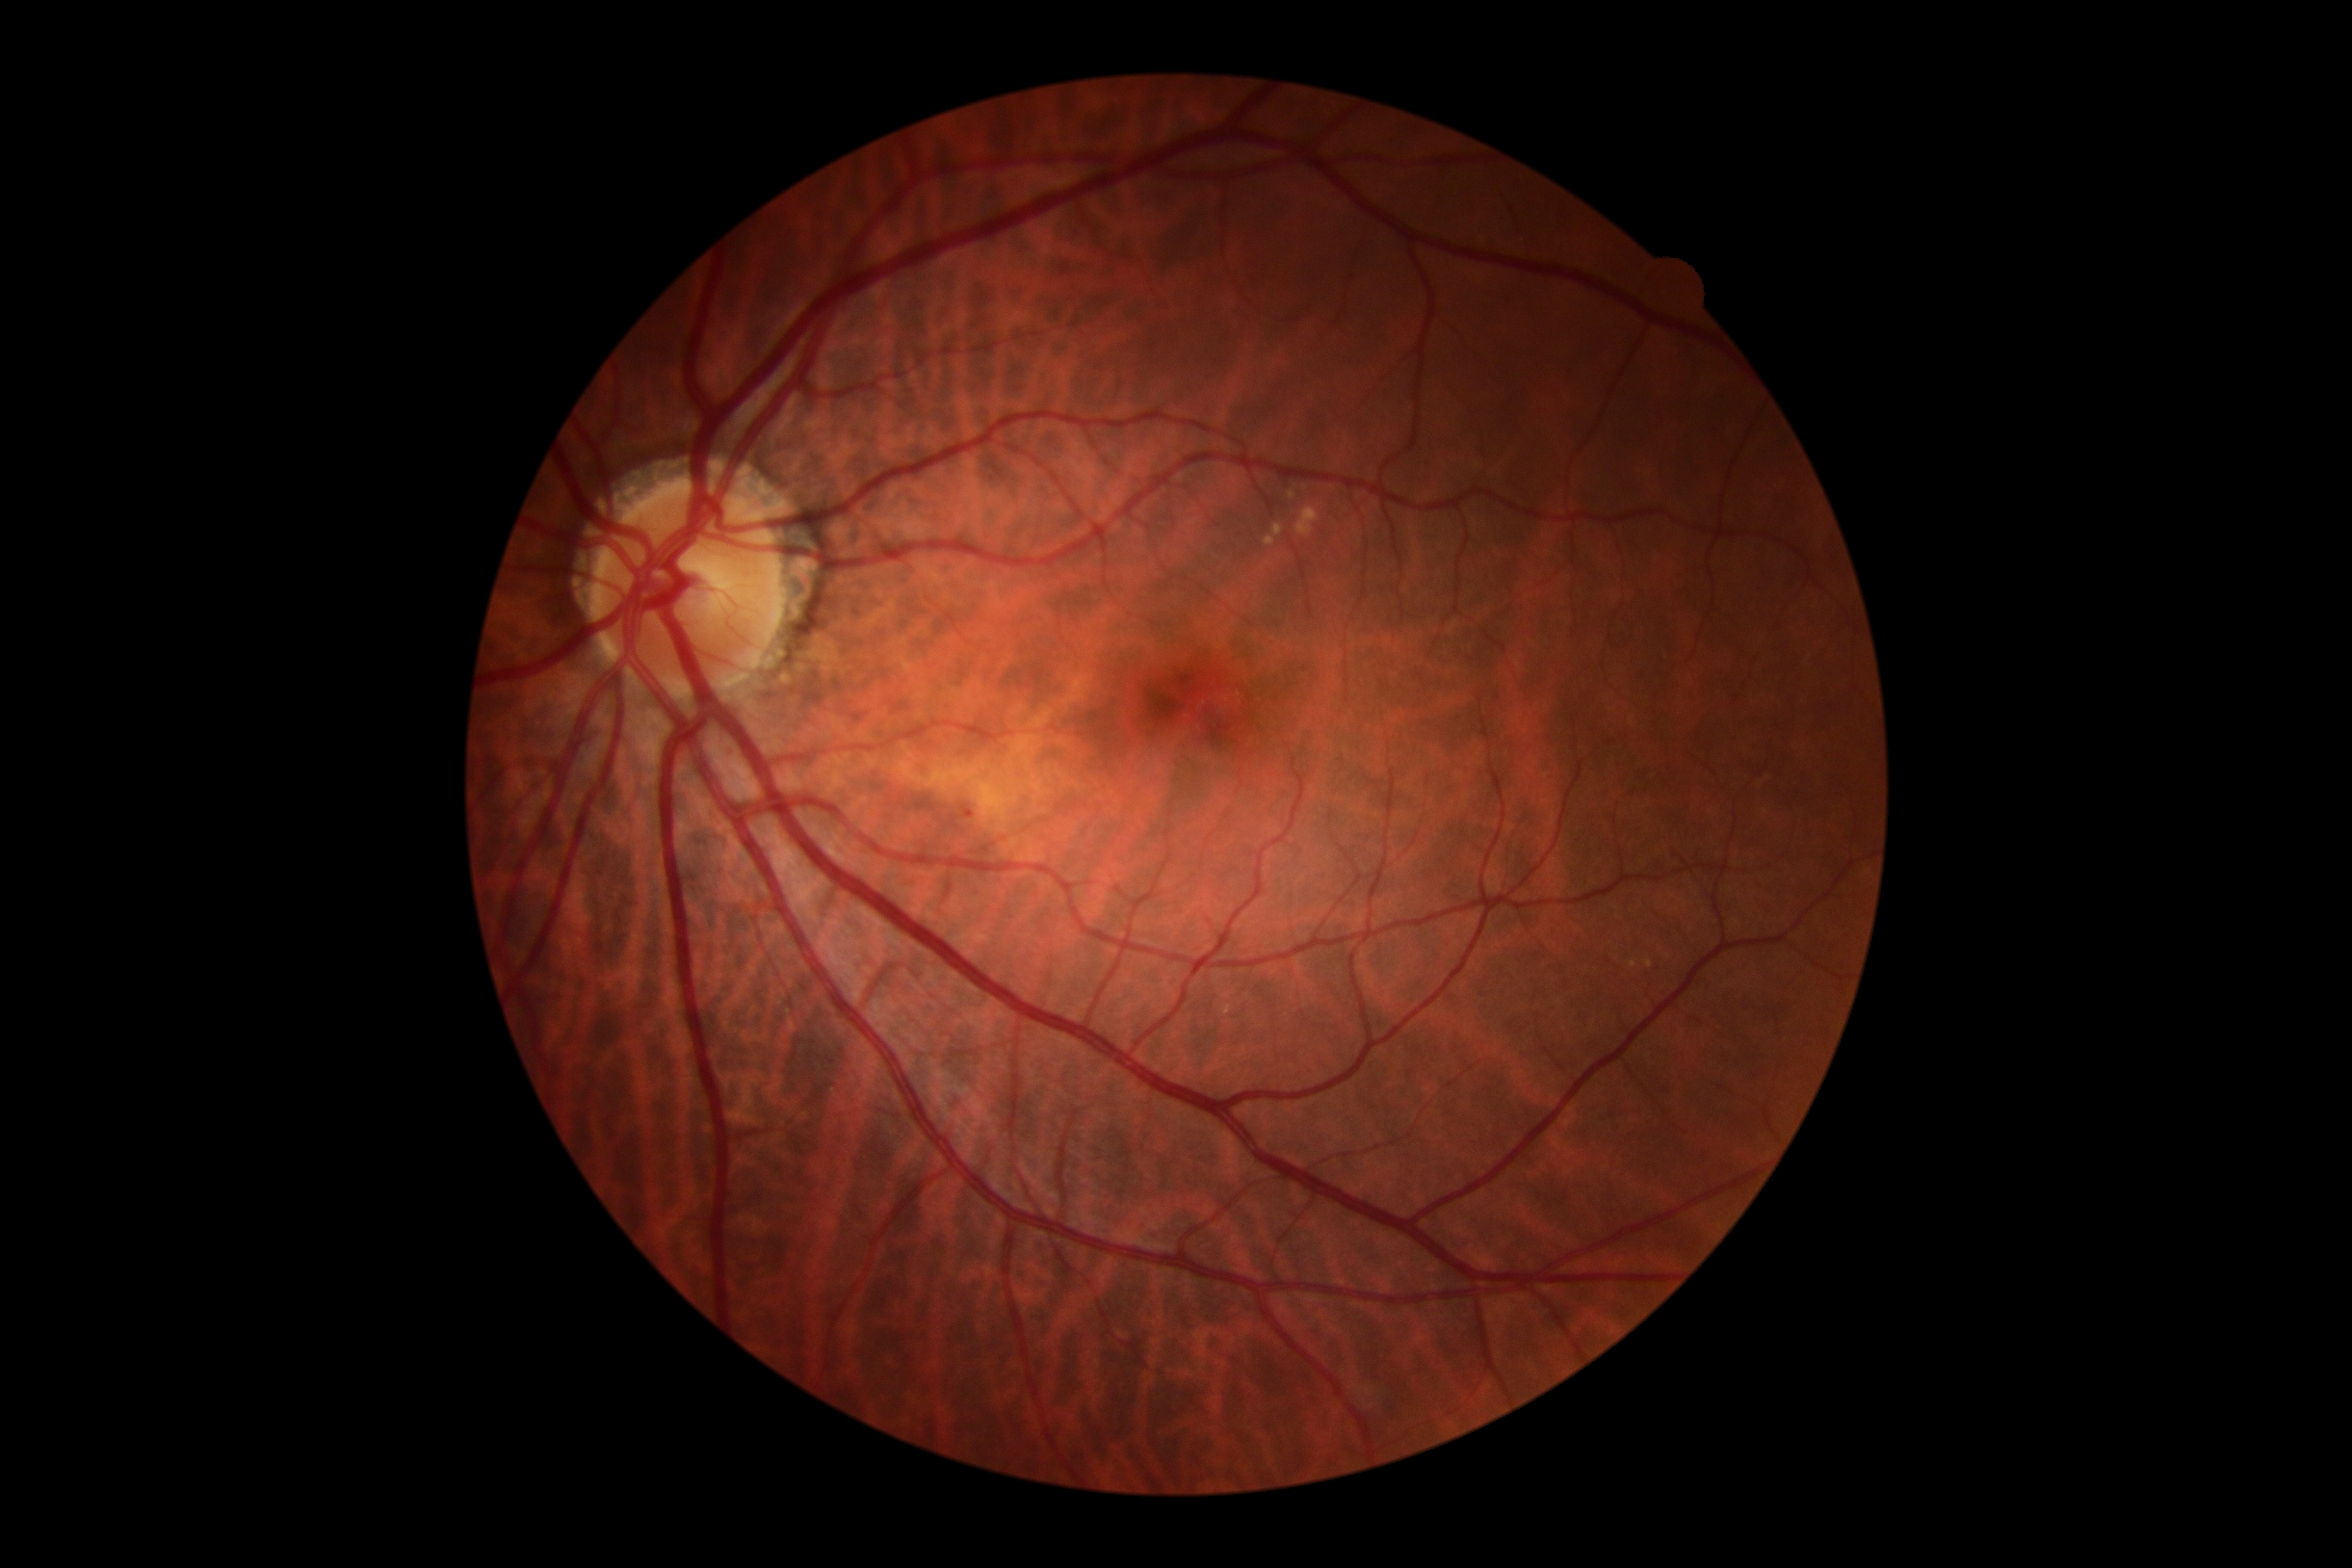 DR grade is 1. DR class: non-proliferative diabetic retinopathy.